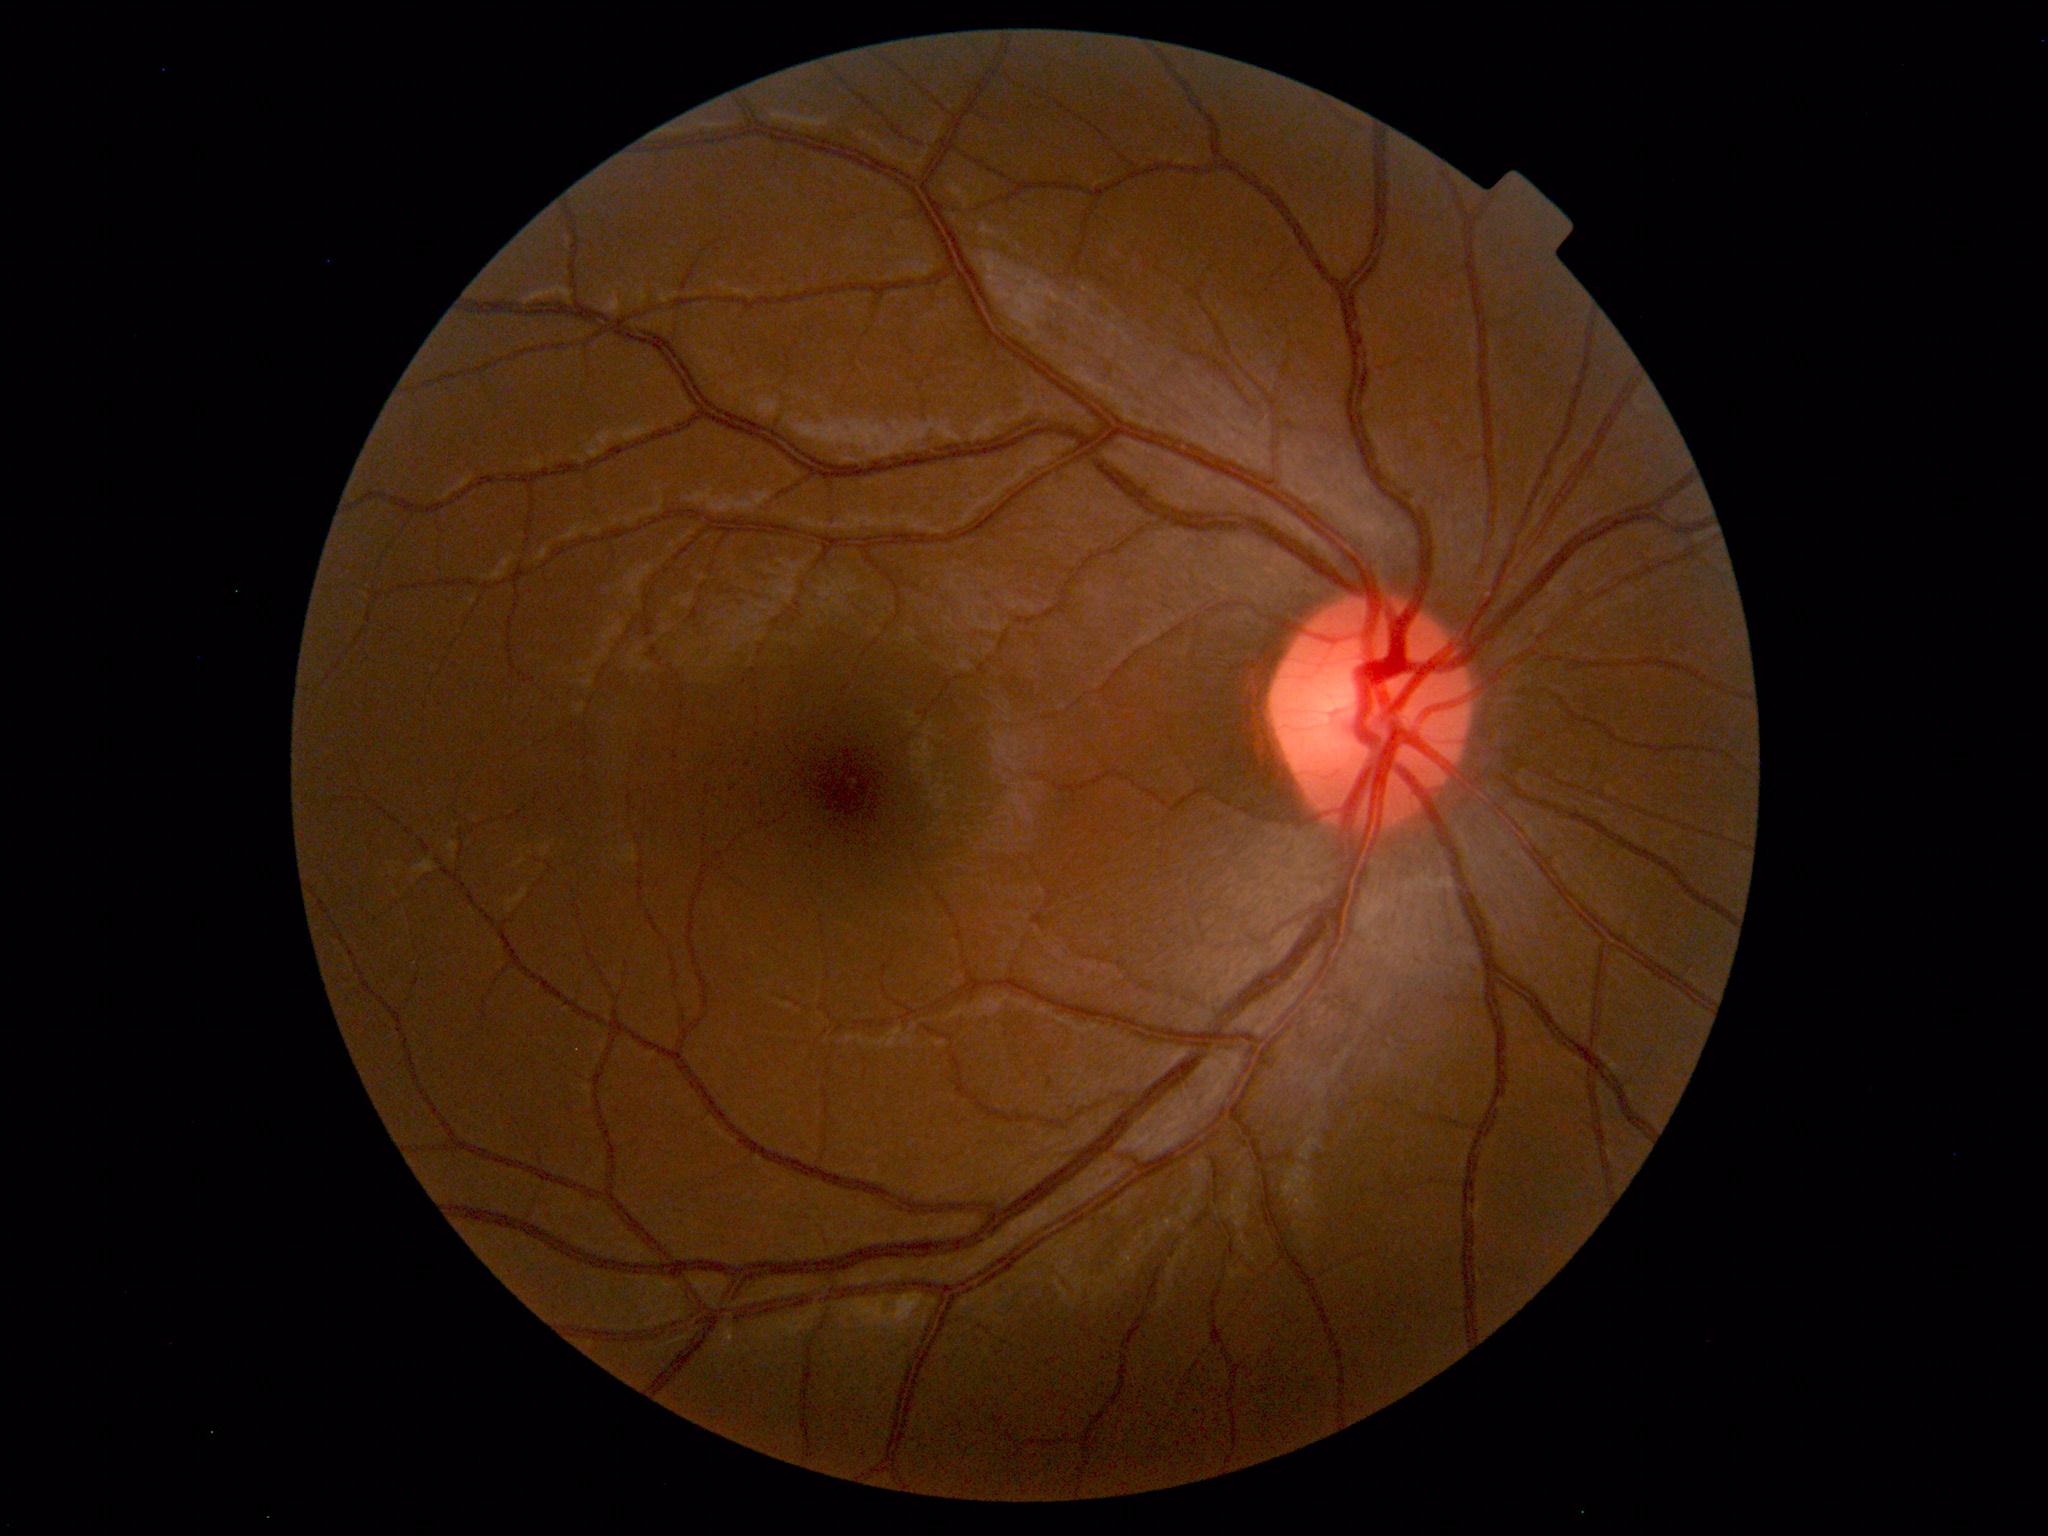 Findings: no abnormalities.